Nonmydriatic. CFP.
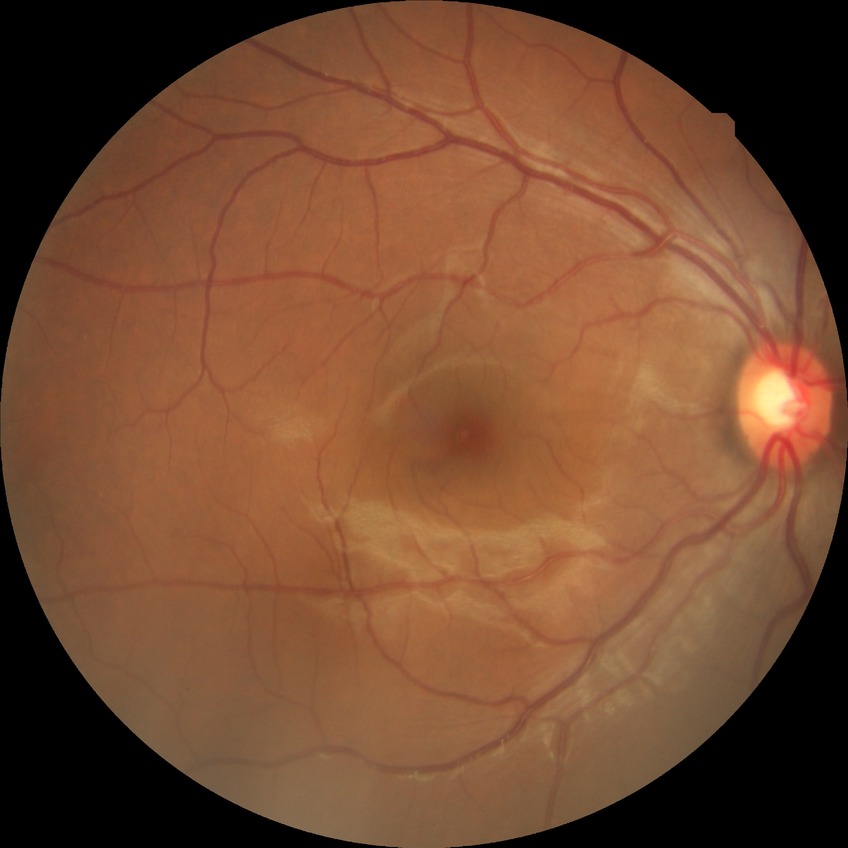

Modified Davis grading is no diabetic retinopathy.